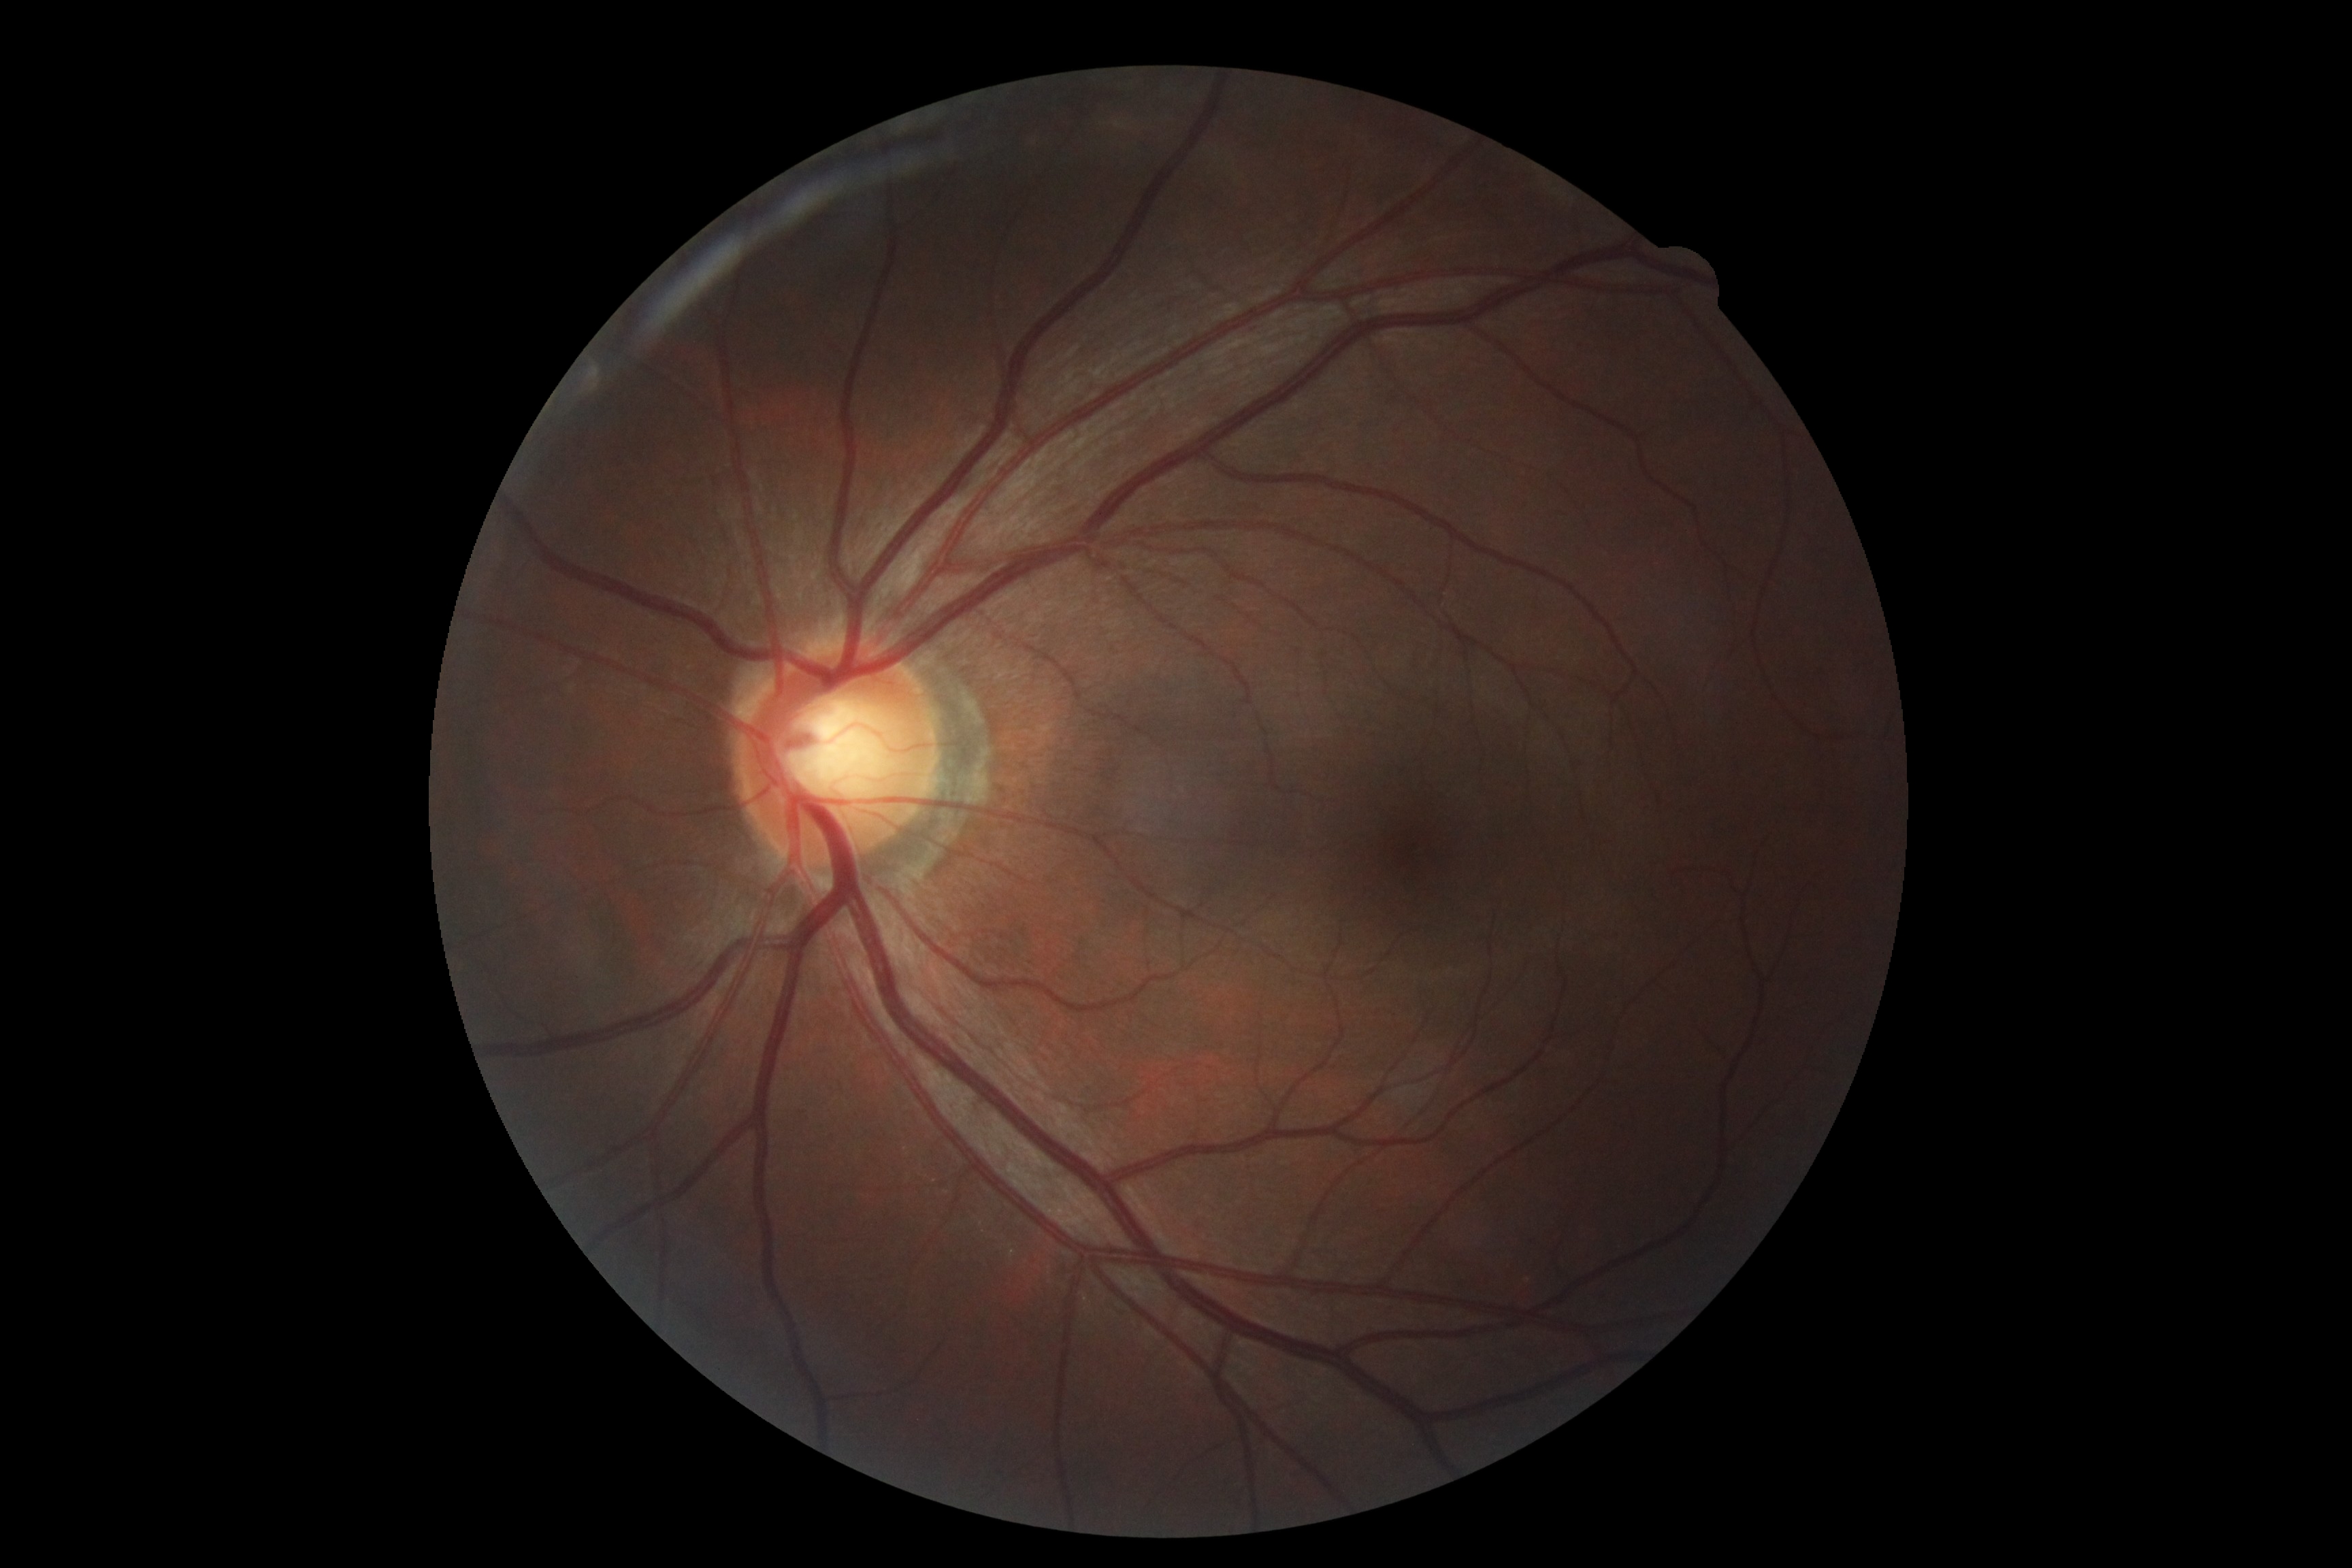
Diabetic retinopathy grade is no apparent retinopathy (0).